1659x2212: 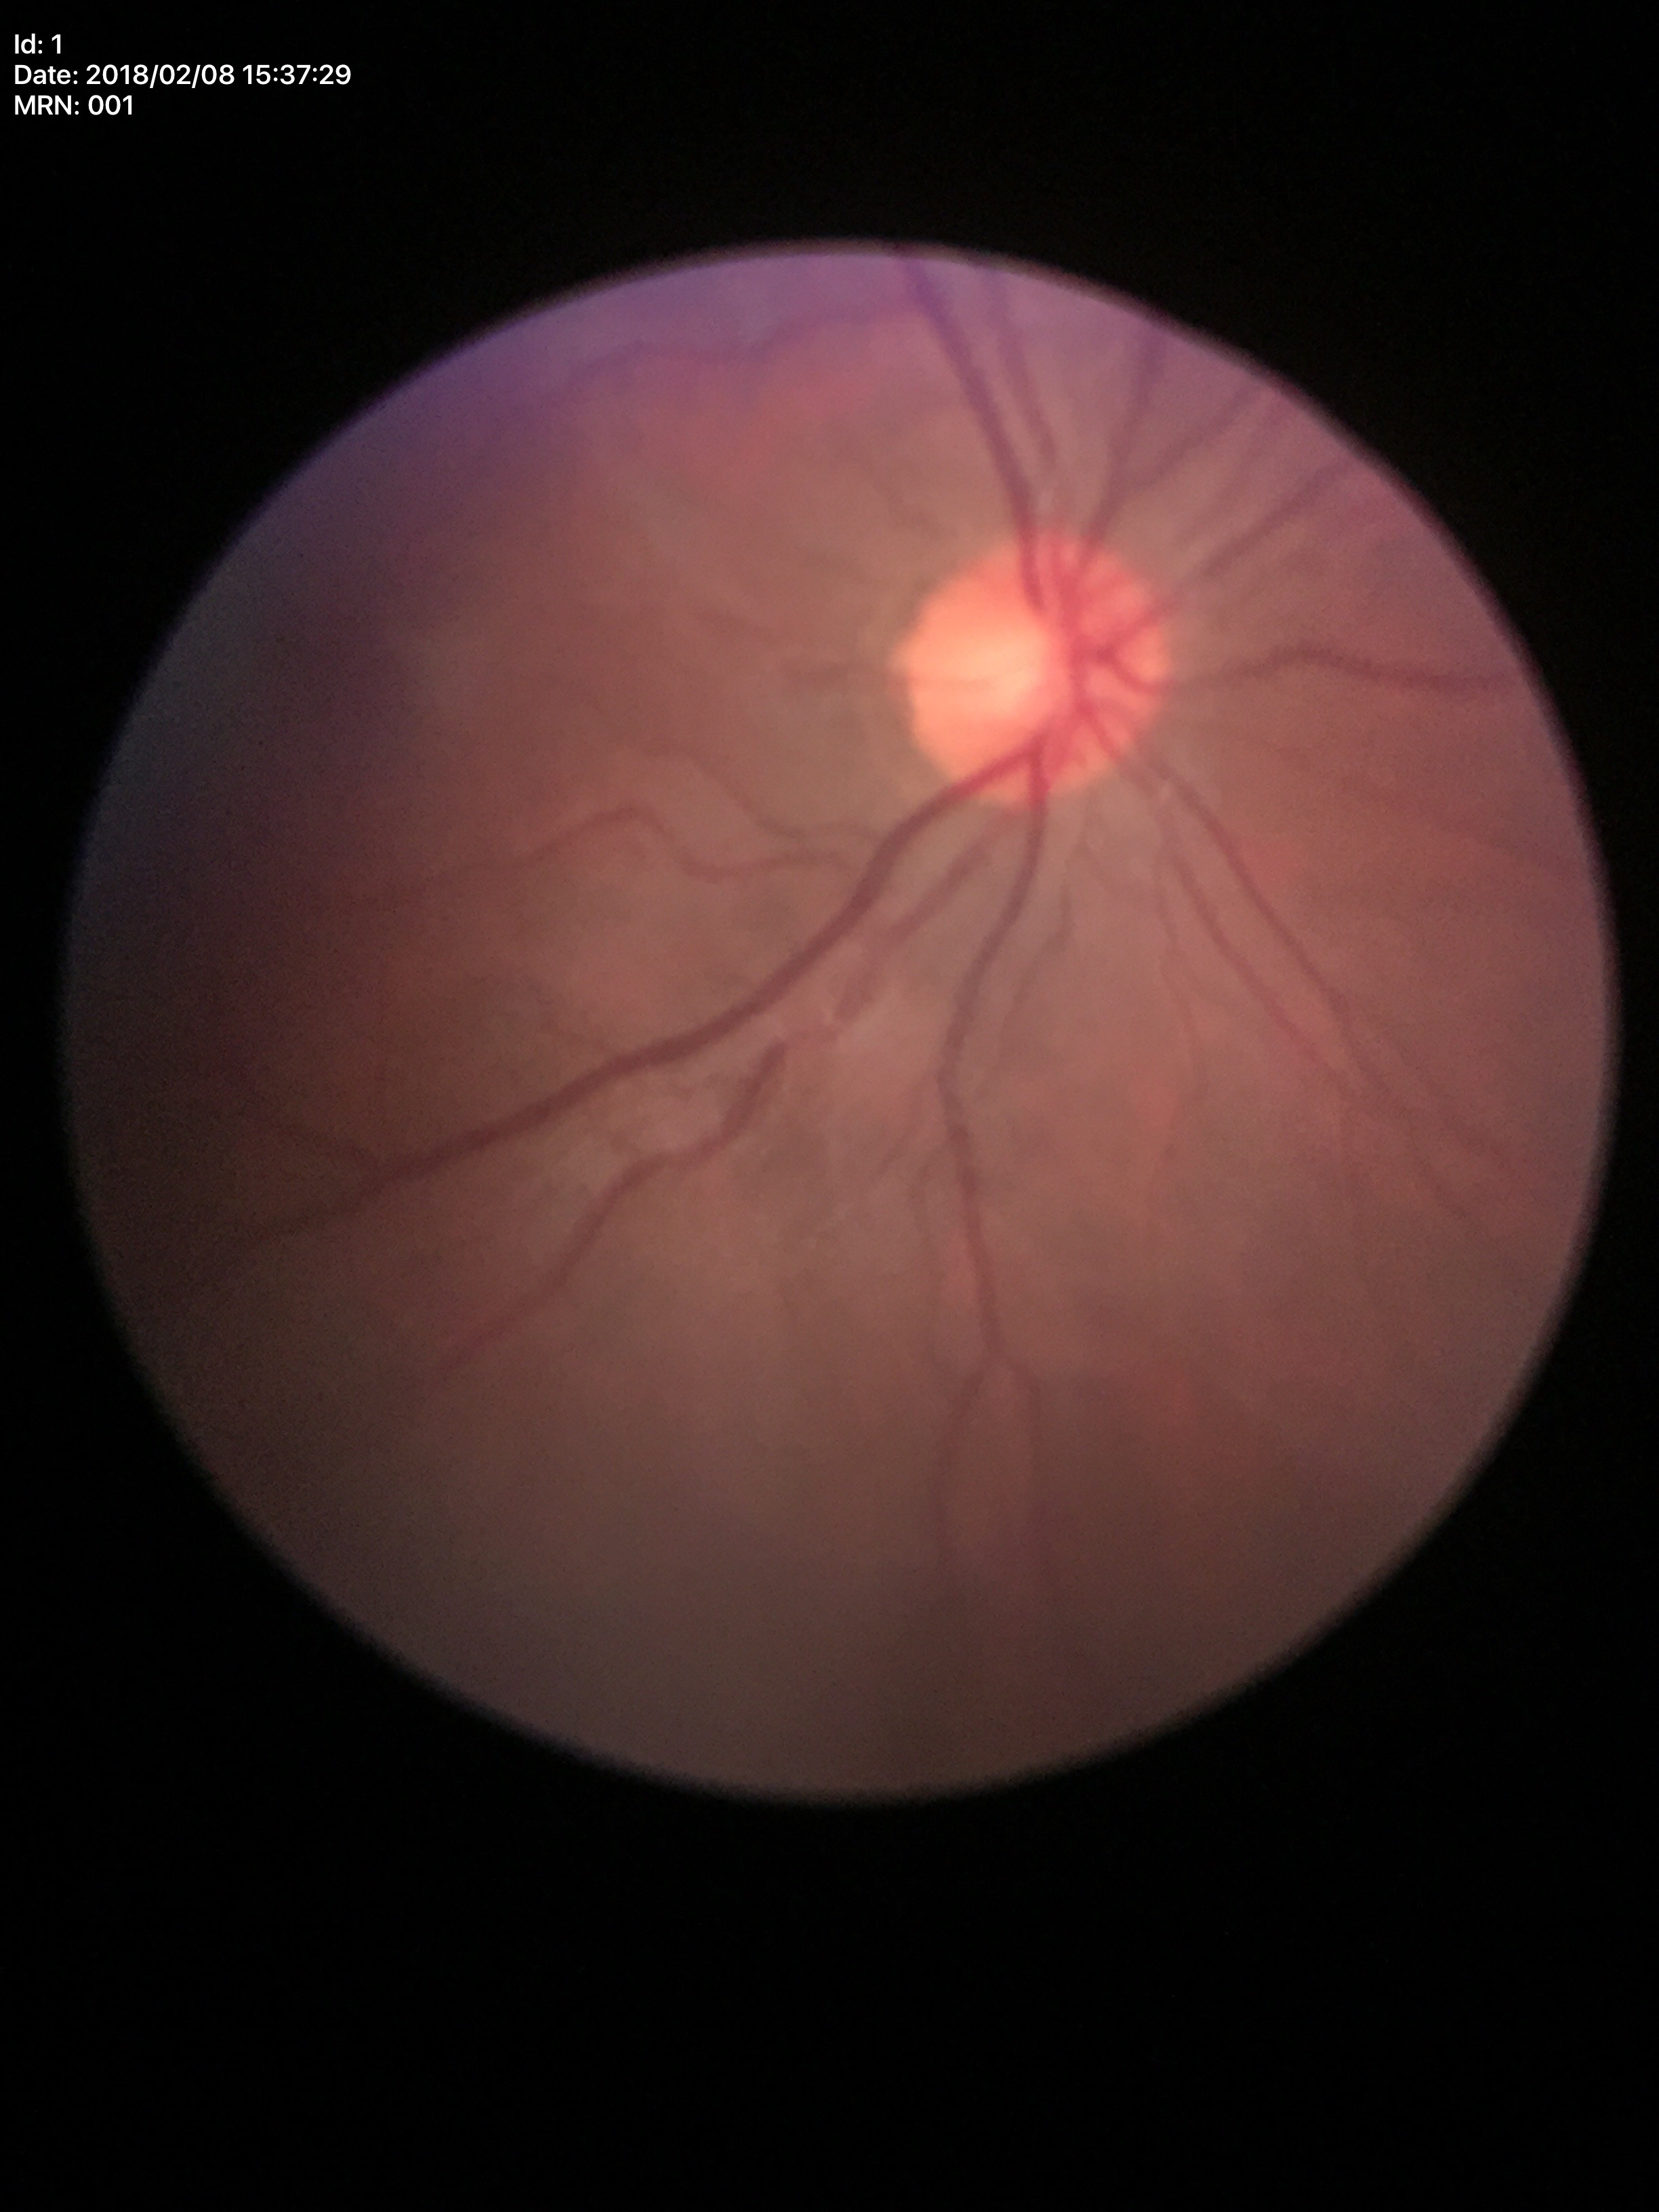 Q: Is there glaucoma suspicion?
A: not suspect (unanimous normal call)
Q: What is the area cup-to-disc ratio?
A: 0.24
Q: What is the vertical cup-to-disc ratio?
A: 0.49